Color fundus image; 45° FOV.
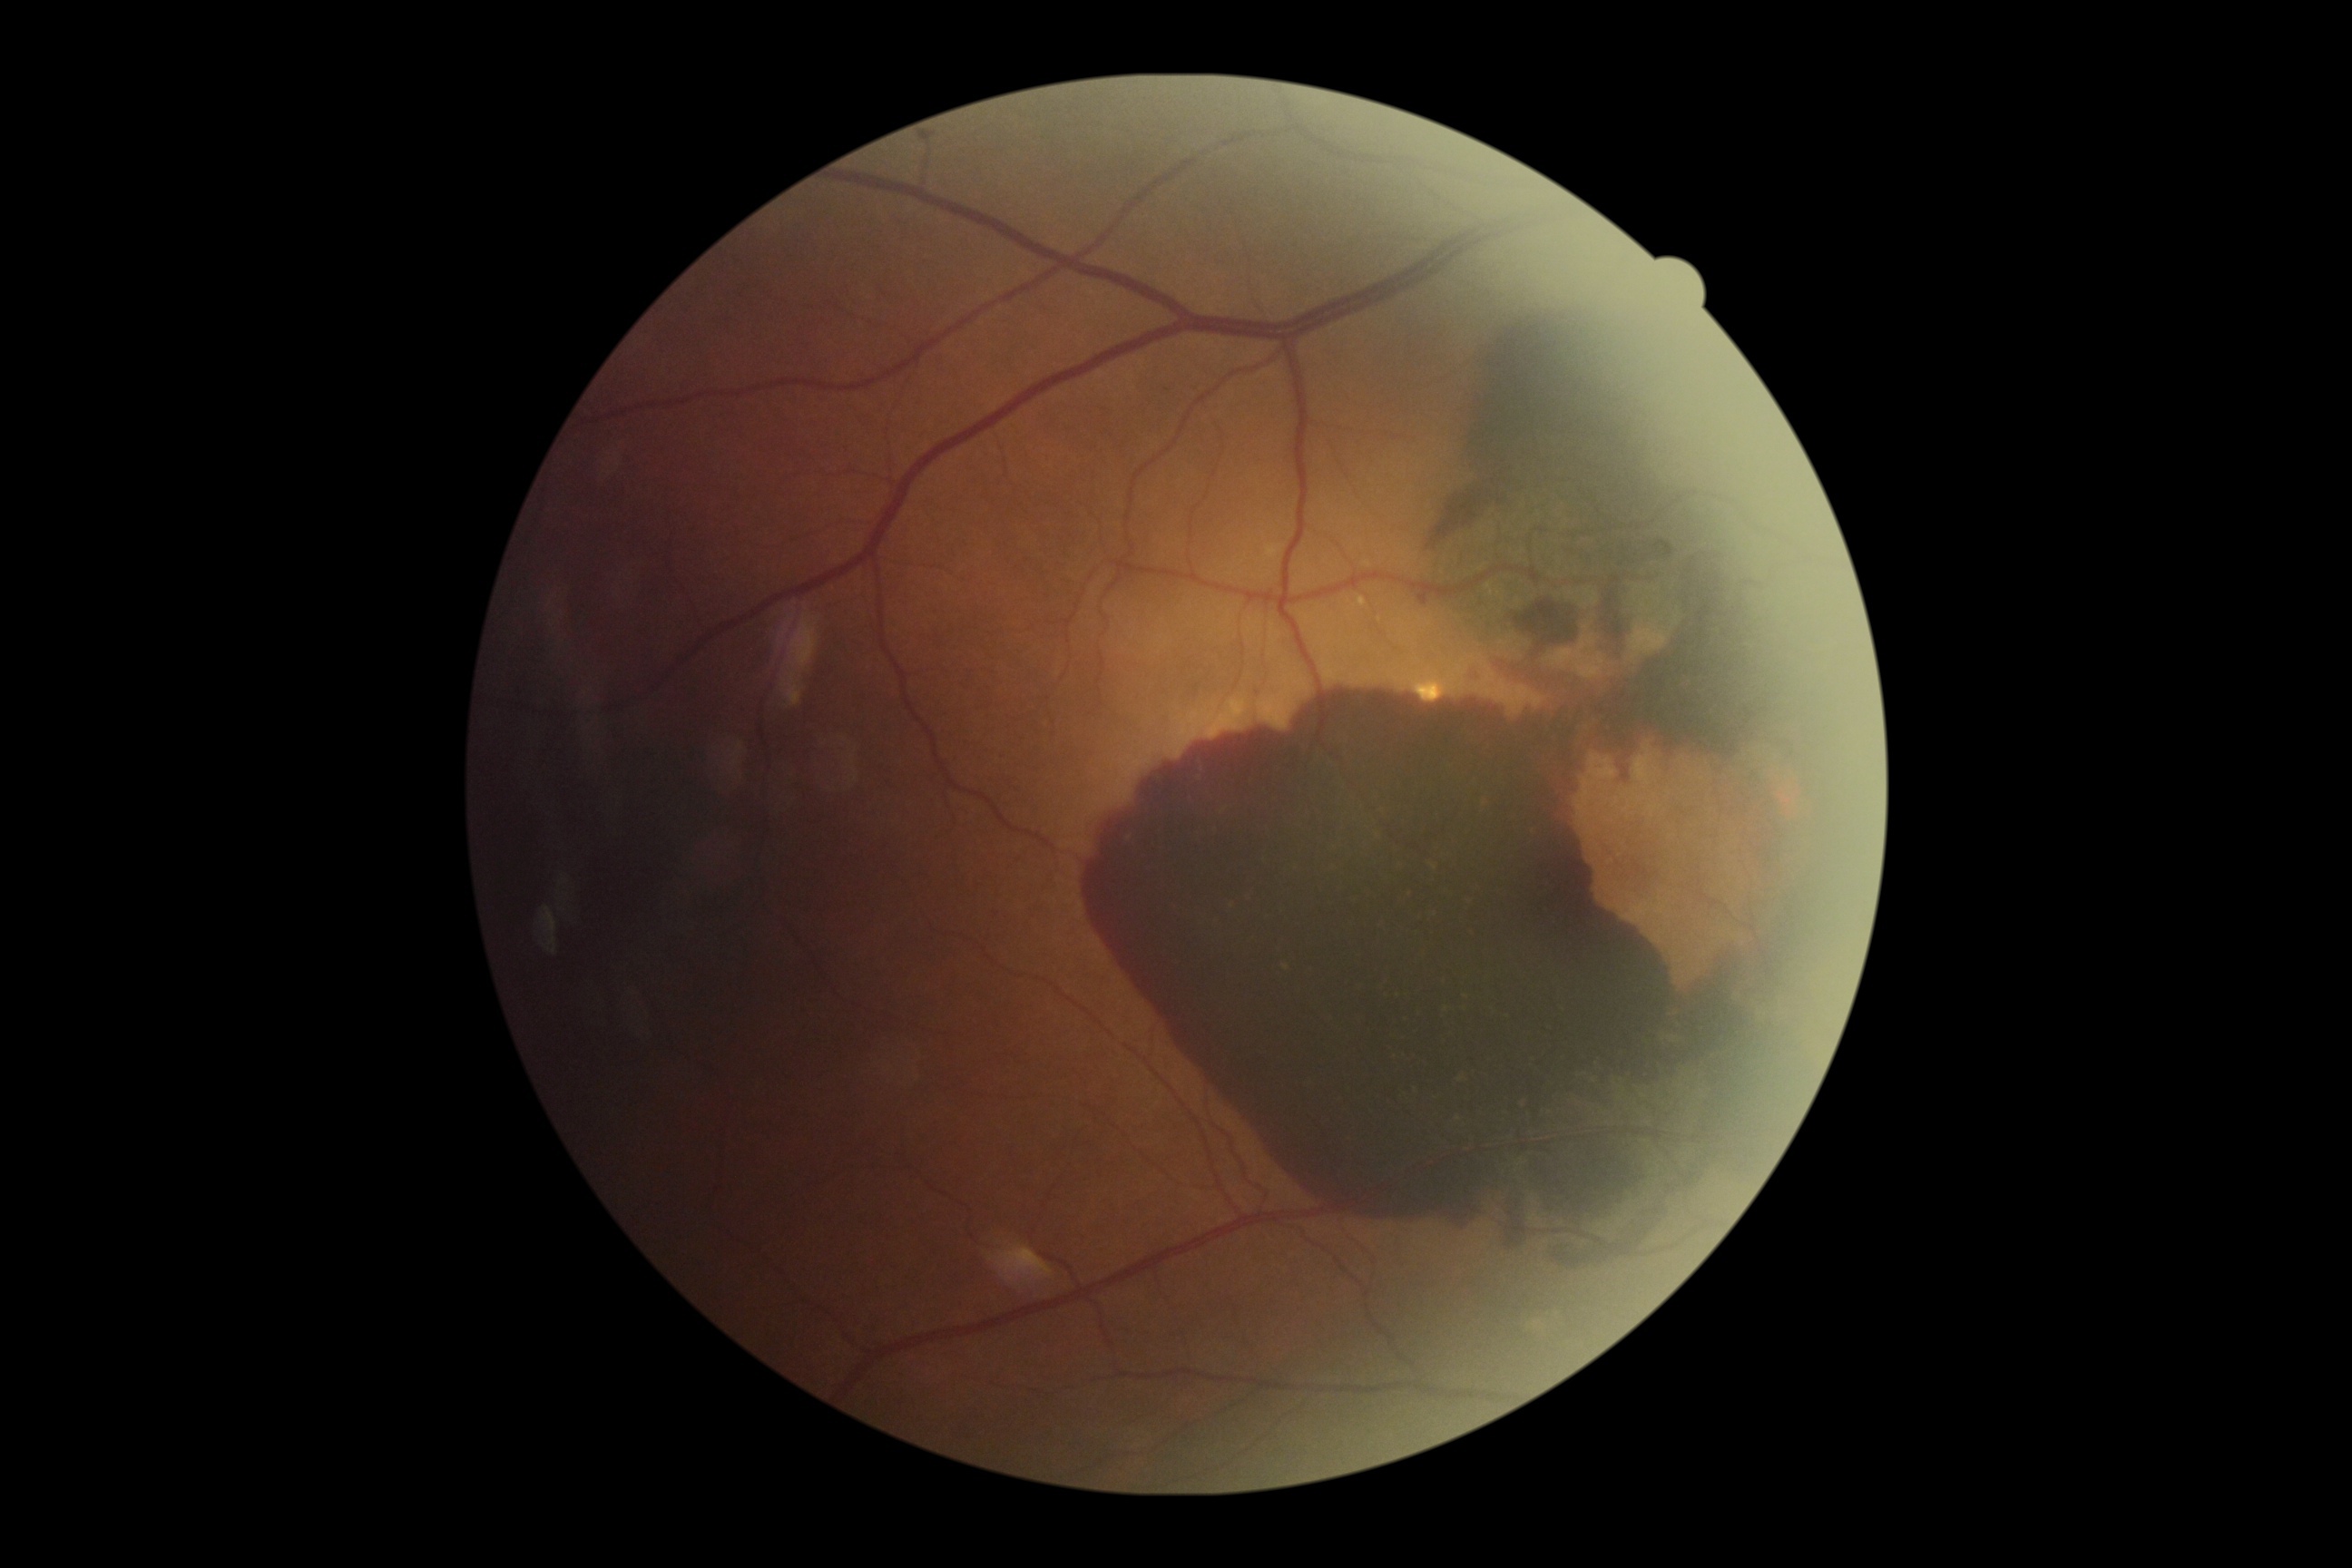
{"dr_grade": "4/4"}